Image size 1240x1240. Phoenix ICON, 100° FOV. Infant wide-field fundus photograph:
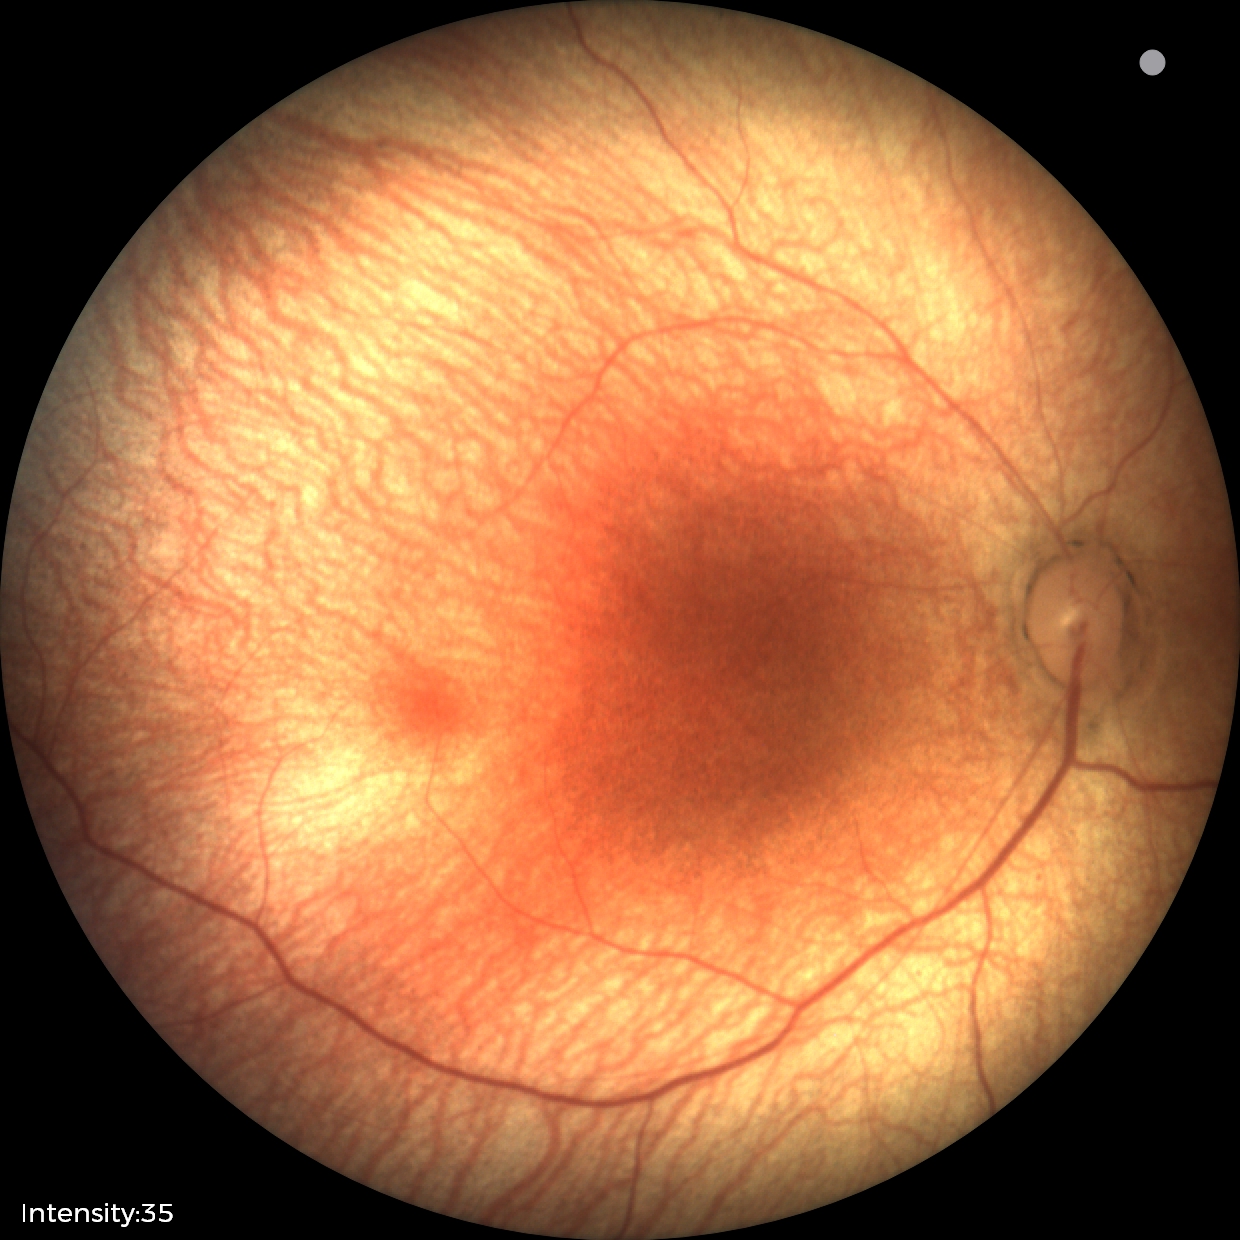

Screening: physiological appearance with no retinal pathology.